Color fundus photograph. 412x310. 45-degree field of view.
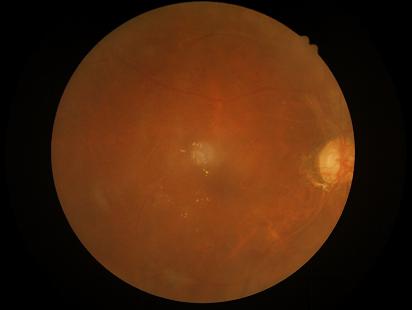
Overall: poor, ungradable
Sharpness: reduced sharpness with visible blur
Contrast: poor dynamic range
Illumination/color: uneven illumination or color cast